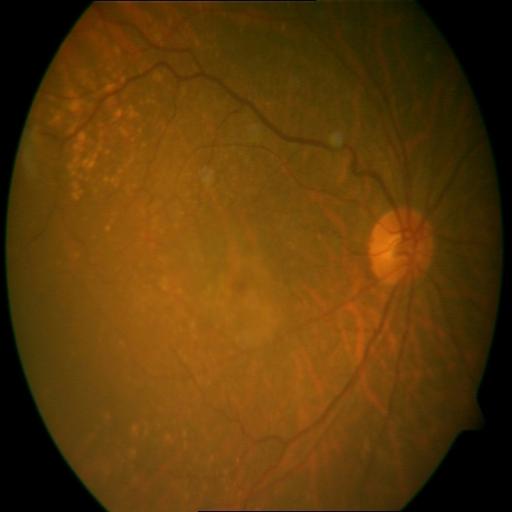
Findings consistent with tessellation & myopia.